240 x 240 pixels, CFP, non-mydriatic.
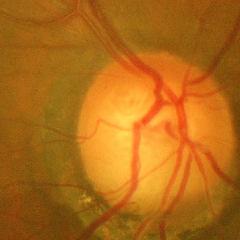 There is evidence of advanced glaucomatous optic neuropathy.